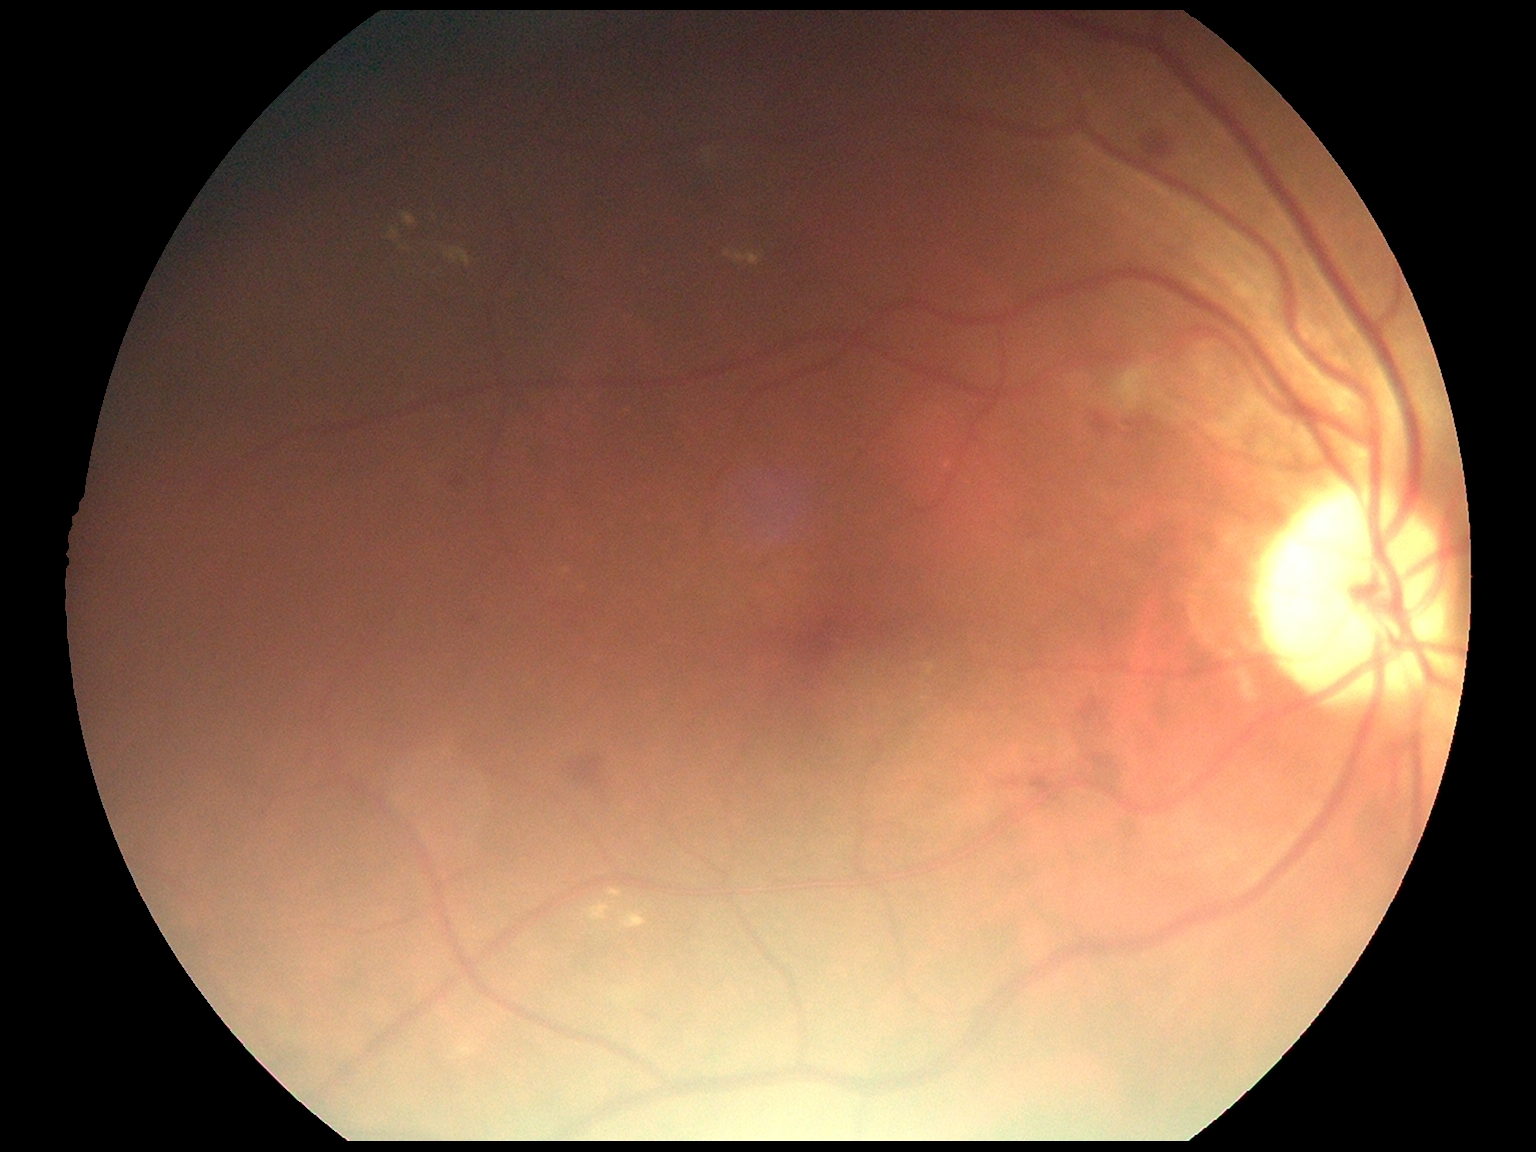

• DR class: non-proliferative diabetic retinopathy
• retinopathy grade: 2 (moderate NPDR)